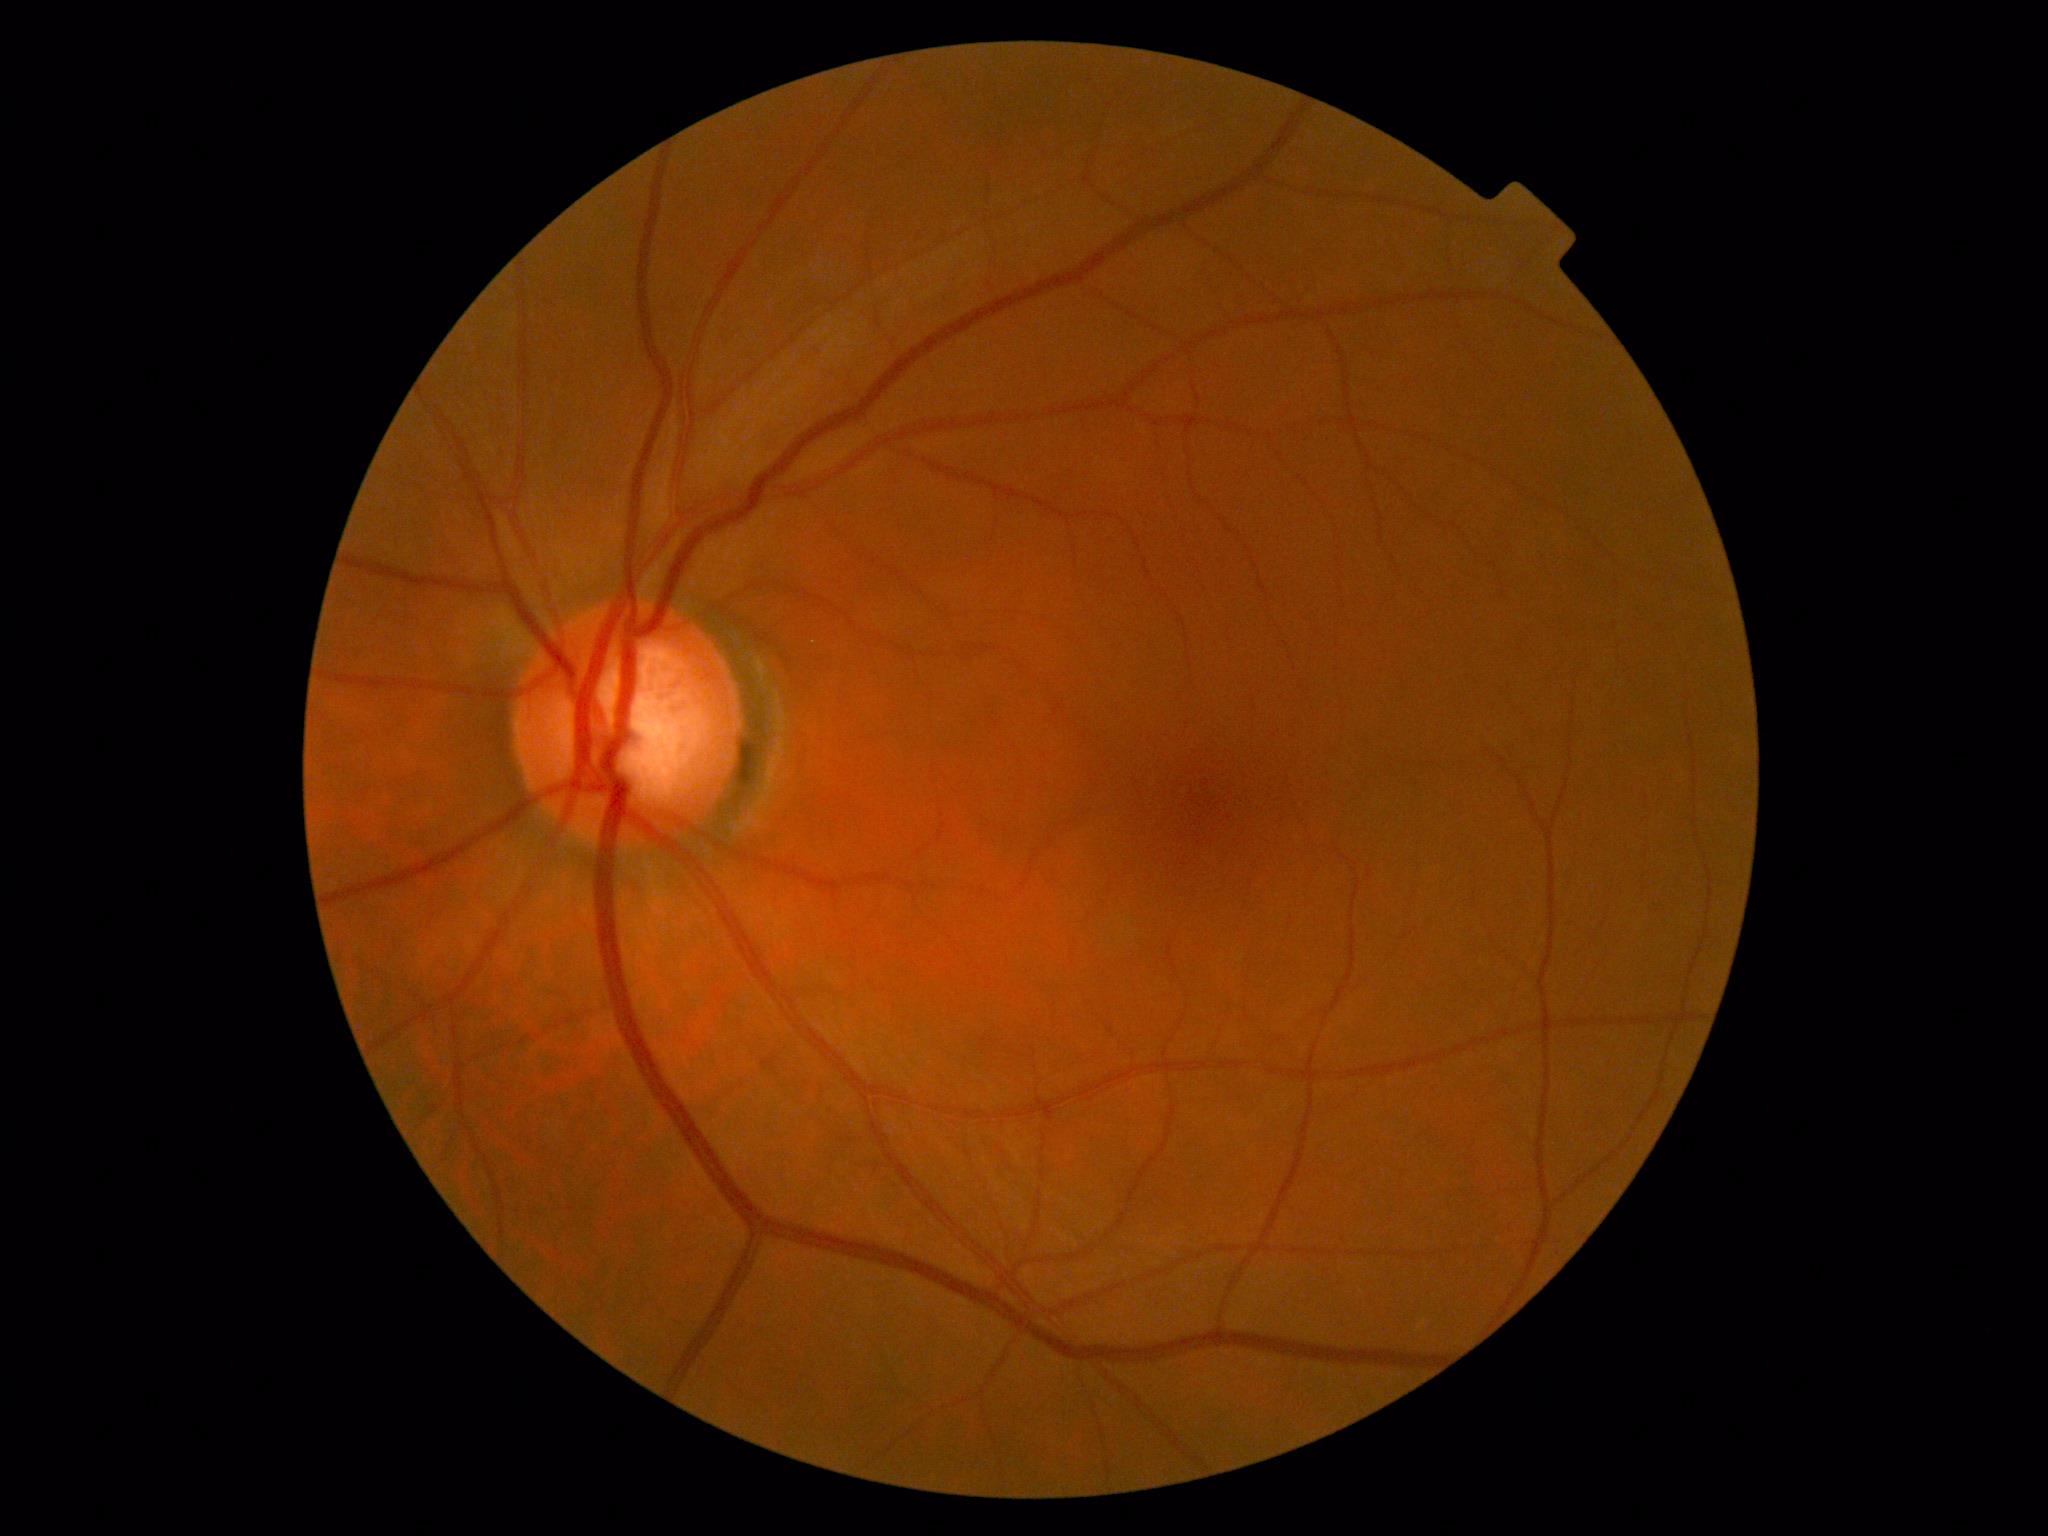
Retinopathy: 0/4.